Acquired on the Phoenix ICON. Infant wide-field fundus photograph:
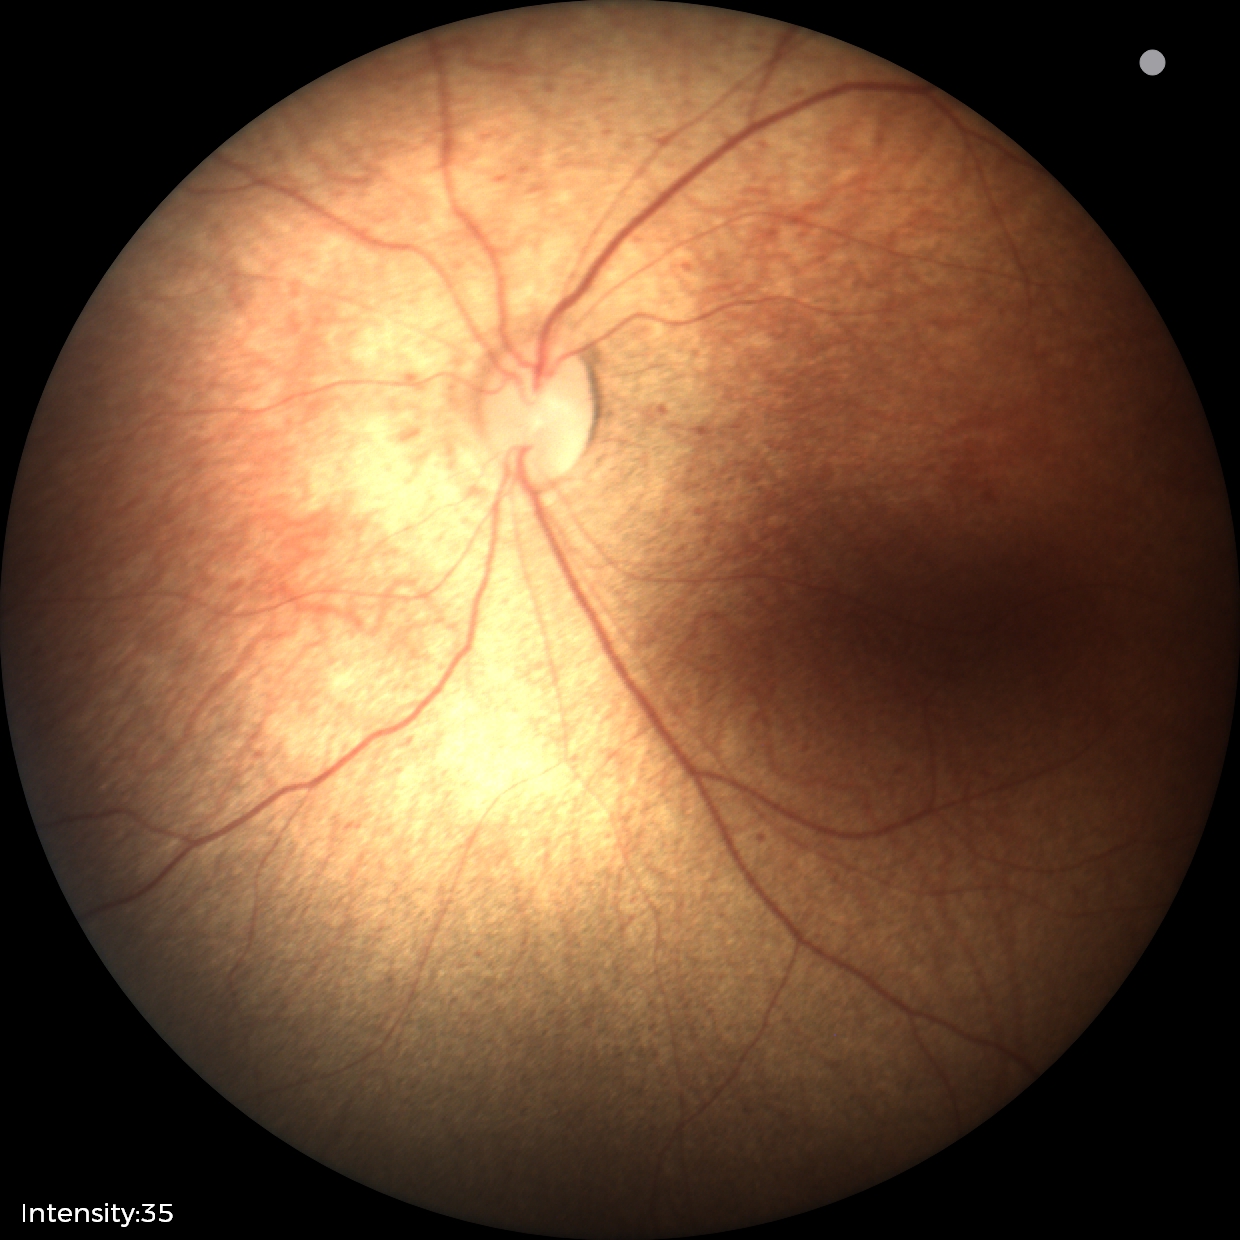 Screening: physiological finding.